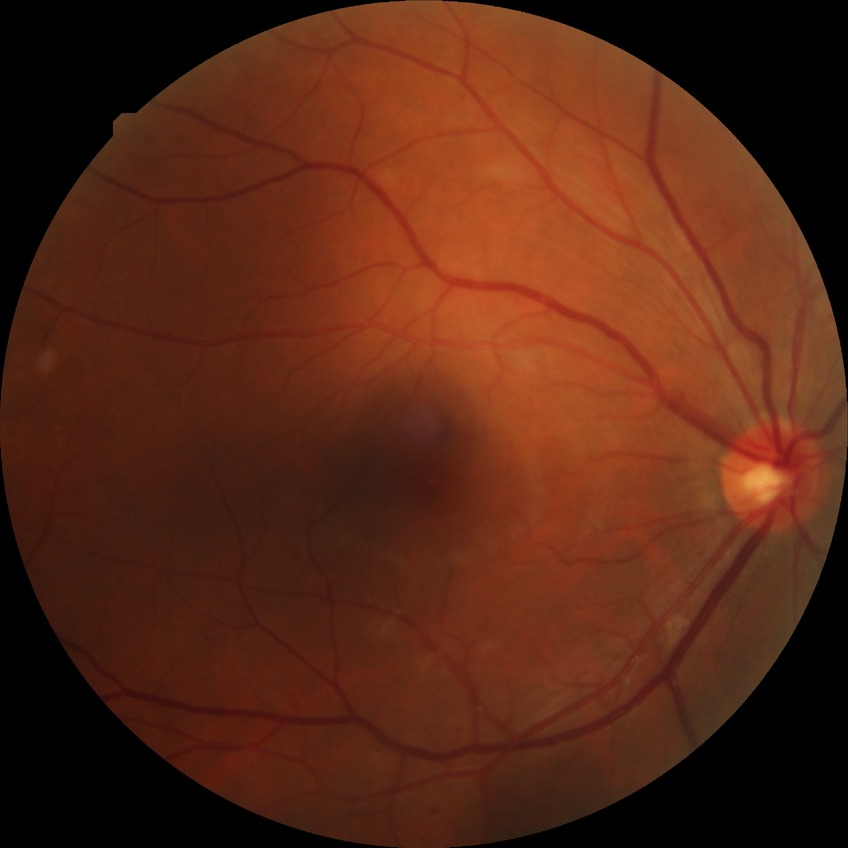
Diabetic retinopathy (DR) is pre-proliferative diabetic retinopathy (PPDR).